CFP:
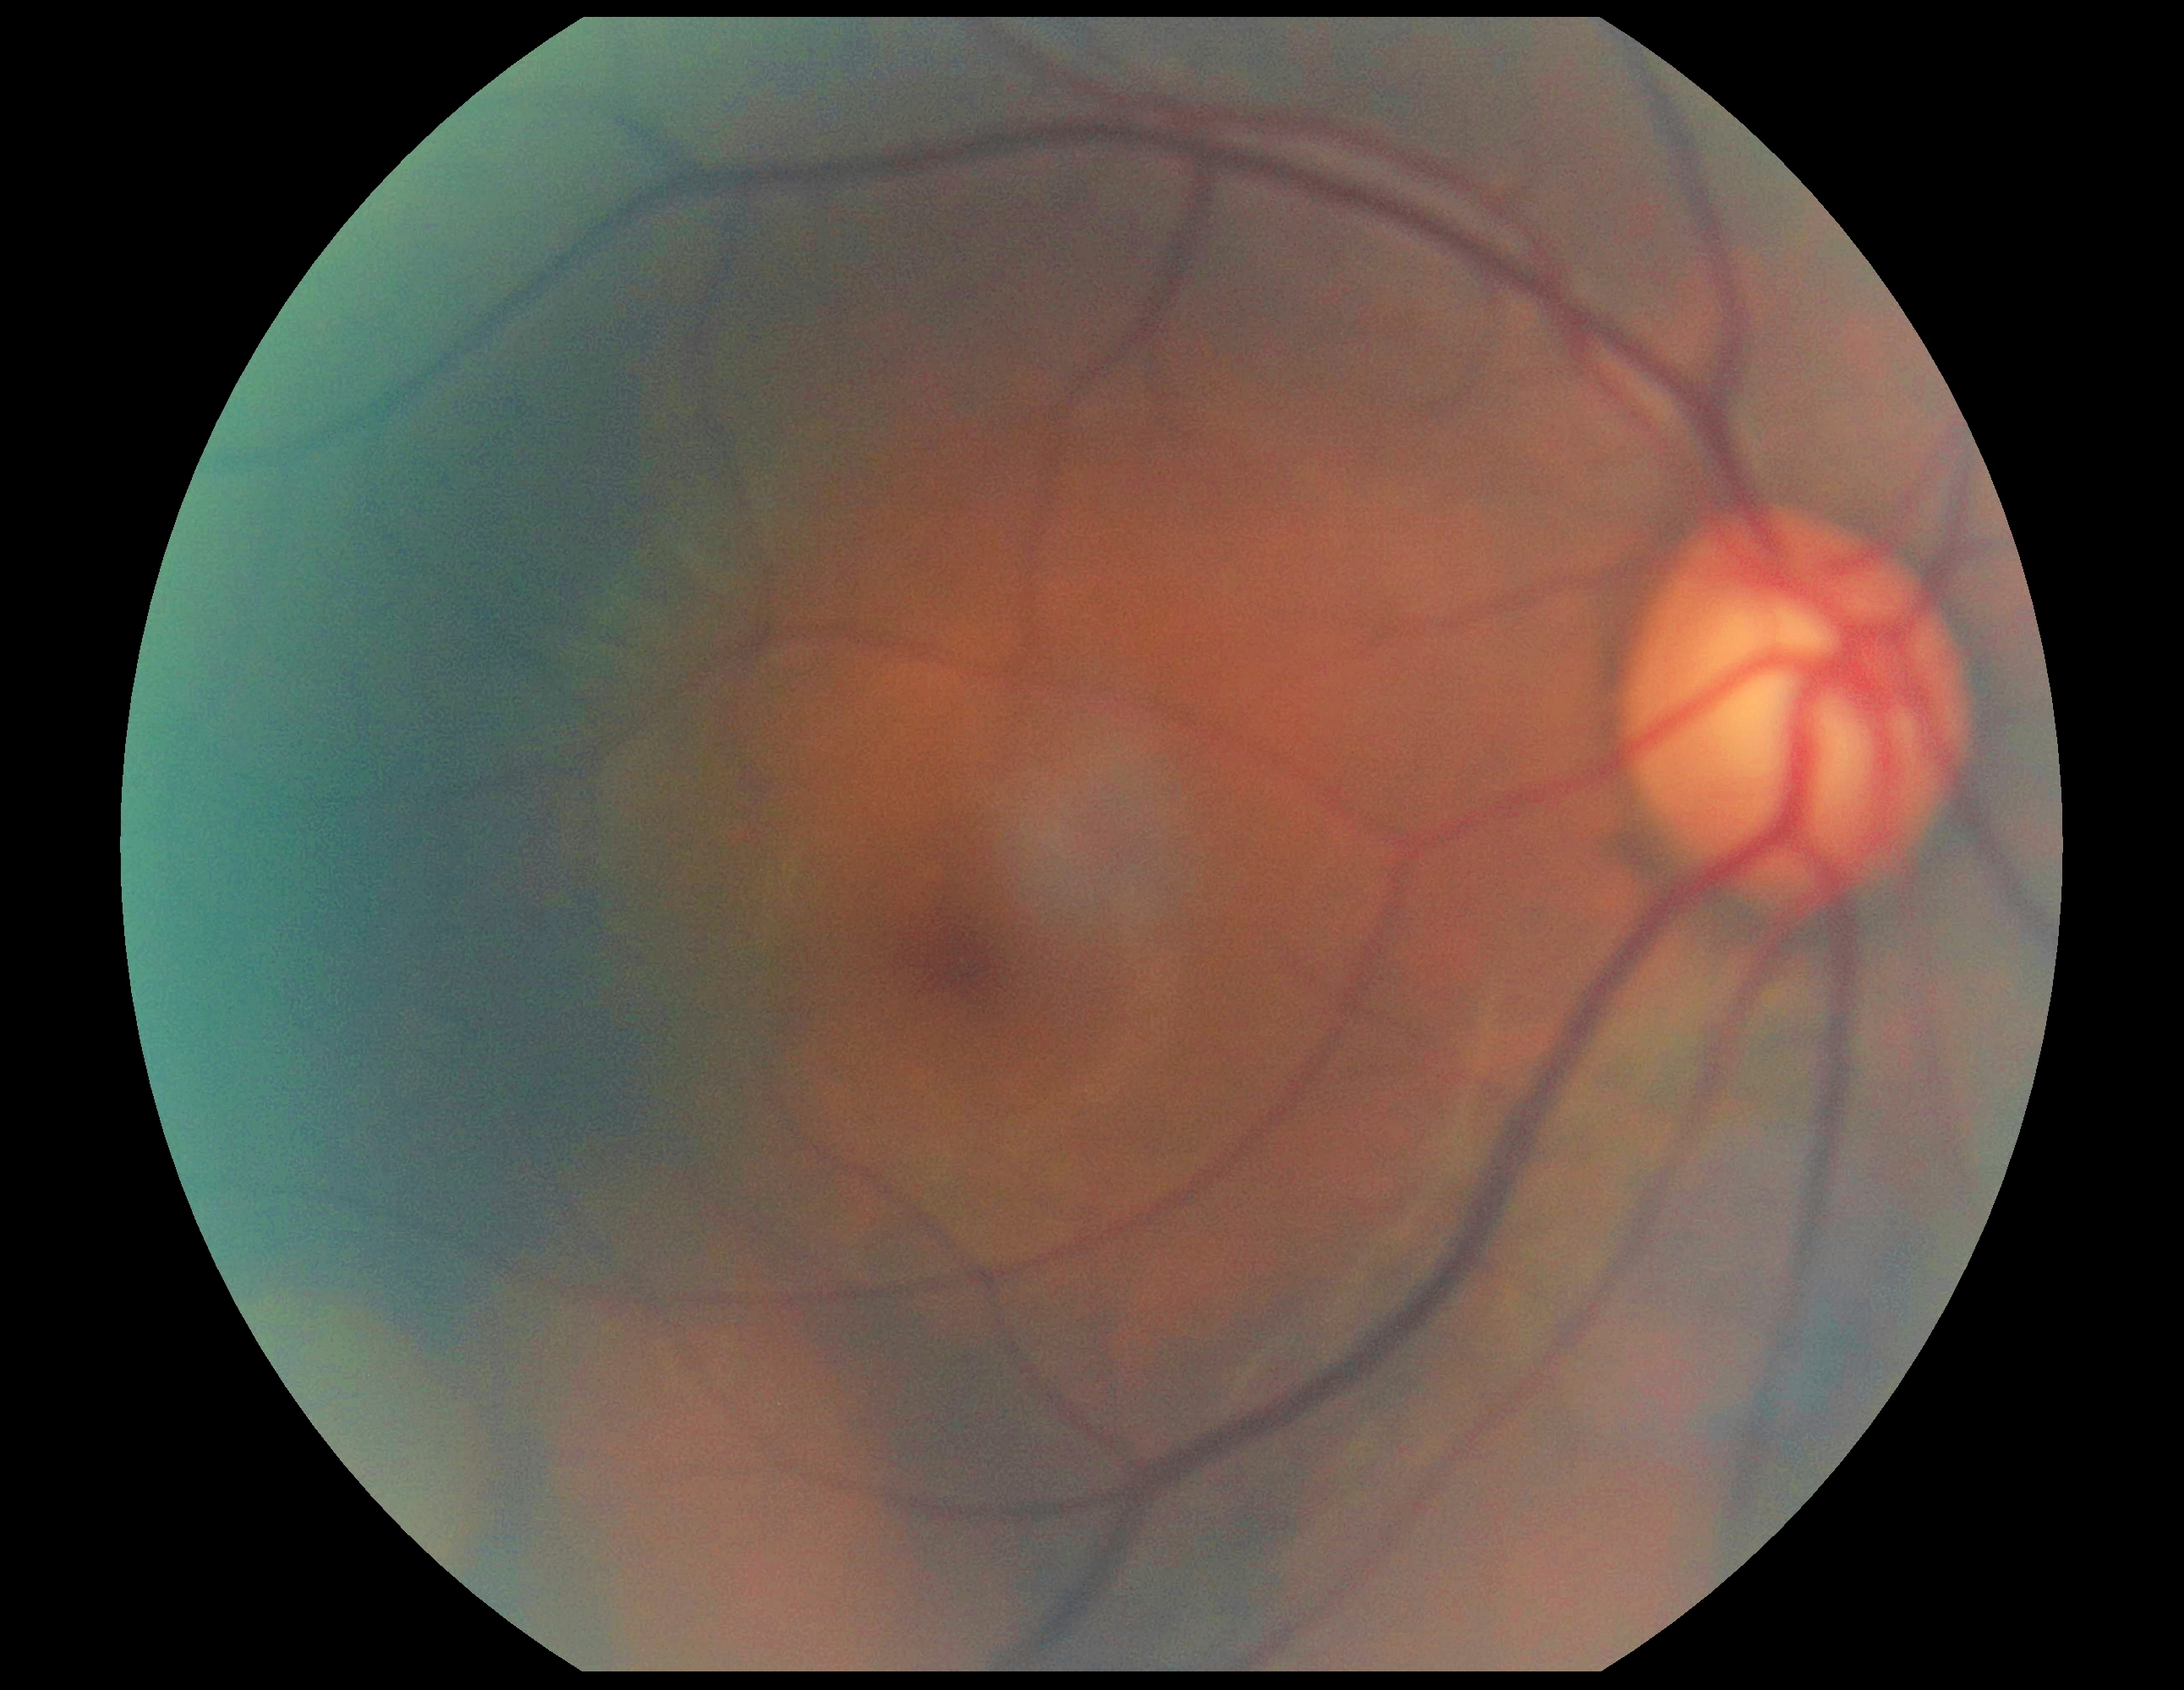 Findings:
* retinopathy: no apparent retinopathy (grade 0)